Pediatric retinal photograph (wide-field); Clarity RetCam 3, 130° FOV; 640 x 480 pixels — 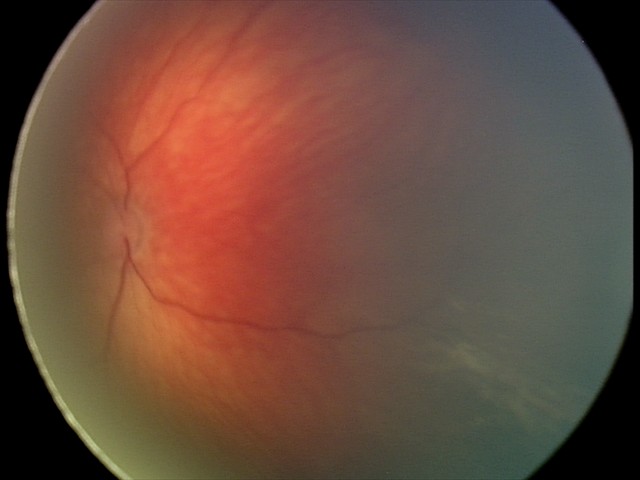

Screening diagnosis: retinal hemorrhages.